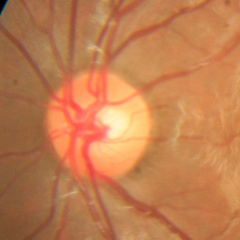
No evidence of glaucoma.